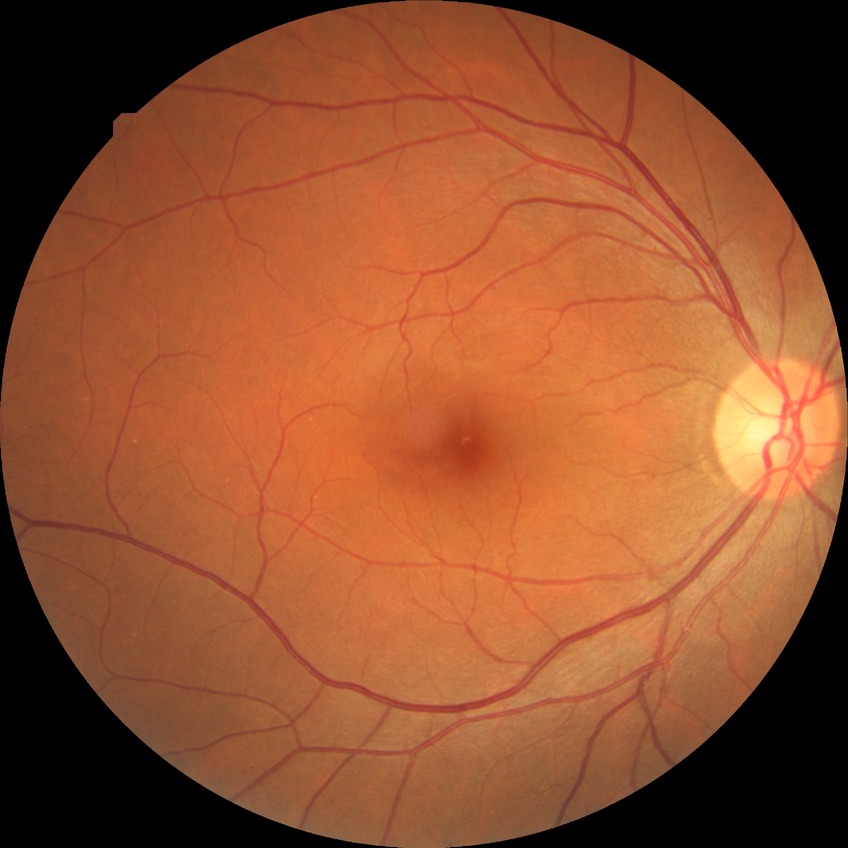
diabetic retinopathy stage: no diabetic retinopathy